Infant wide-field fundus photograph: 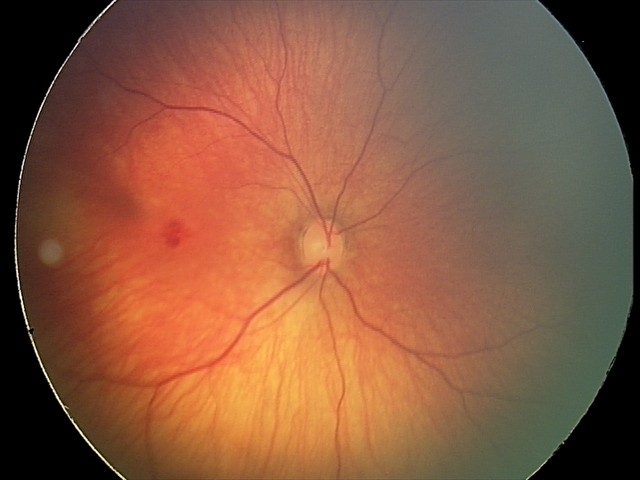 Screening diagnosis = retinal hemorrhages.